Wide-field contact fundus photograph of an infant. Acquired on the Natus RetCam Envision. 1440 x 1080 pixels: 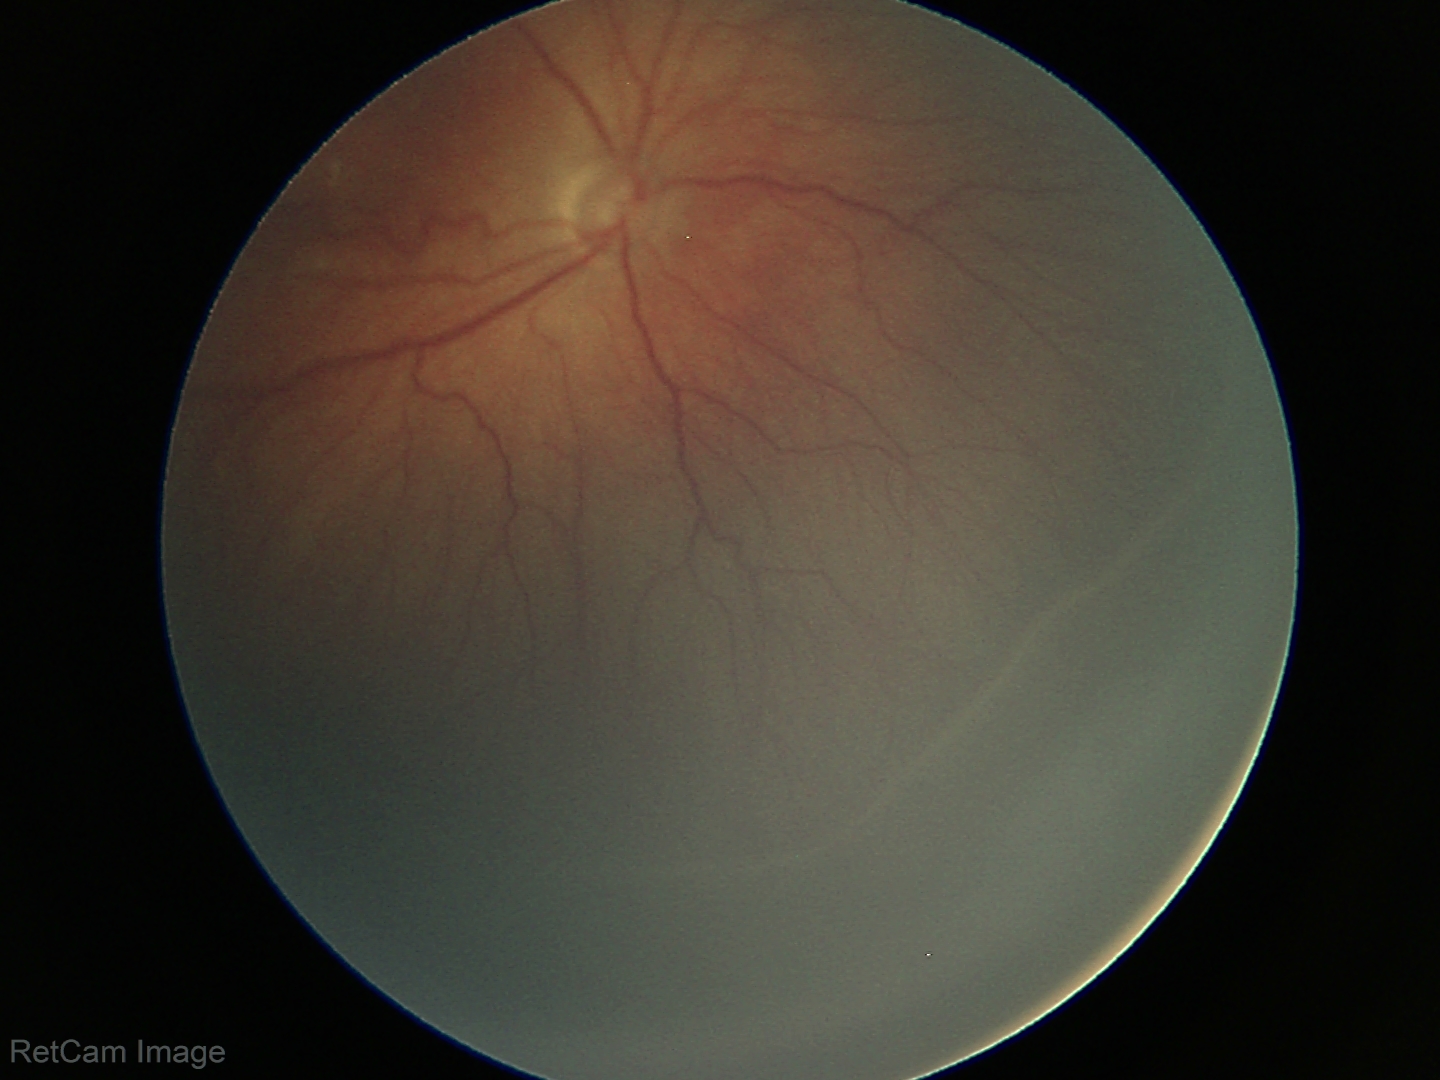 Q: Is plus disease present?
A: no plus disease
Q: What was the screening finding?
A: ROP stage 3